Graded on the modified Davis scale.
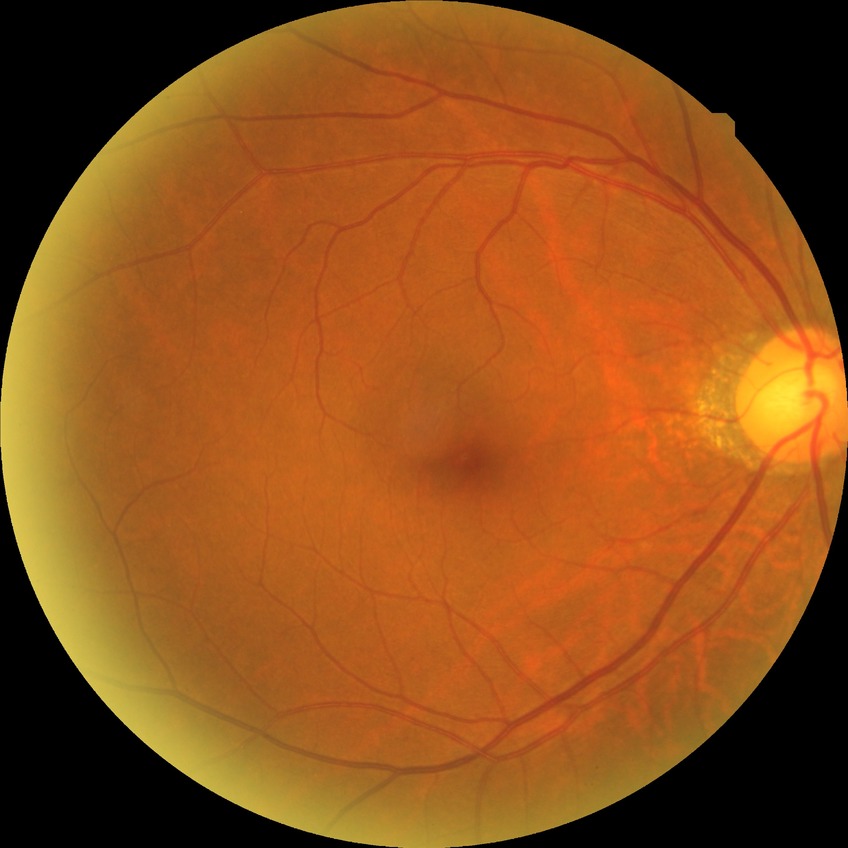

DR is NDR.